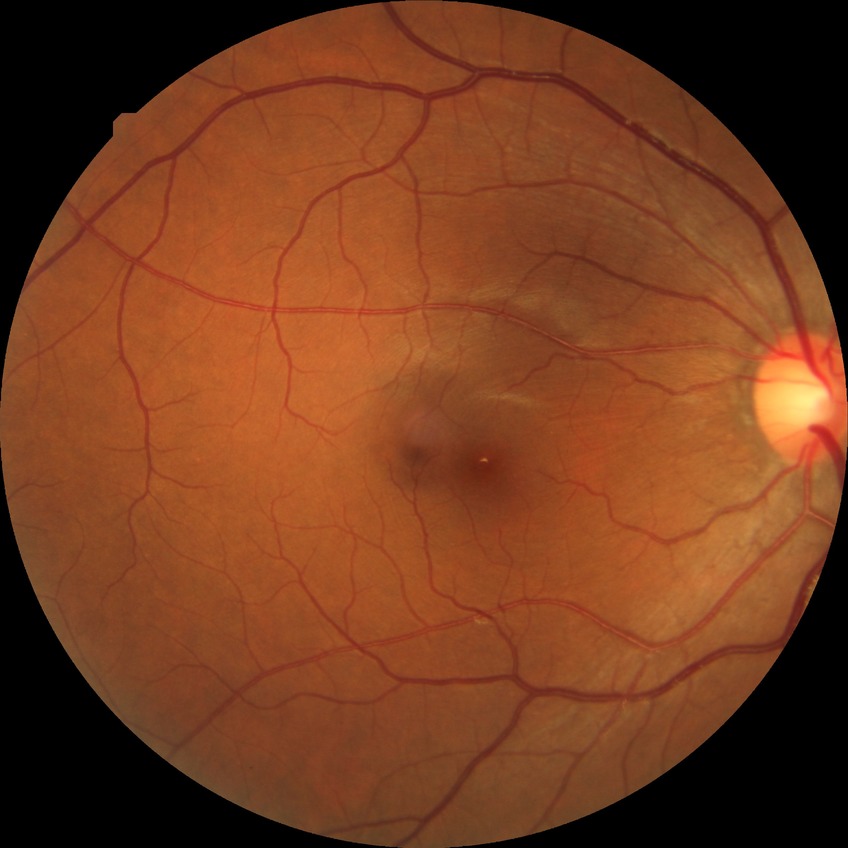
DR stage: NDR.